Nonmydriatic.
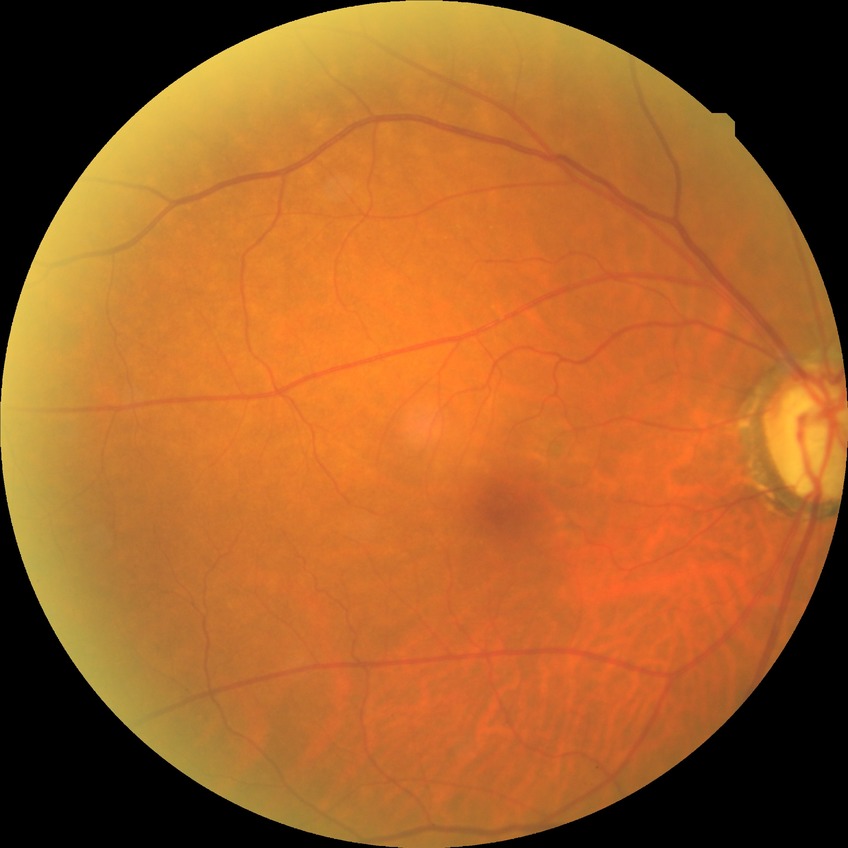

Davis stage is NDR.